Image size 1240x1240 · captured with the Phoenix ICON (100° field of view) · wide-field contact fundus photograph of an infant — 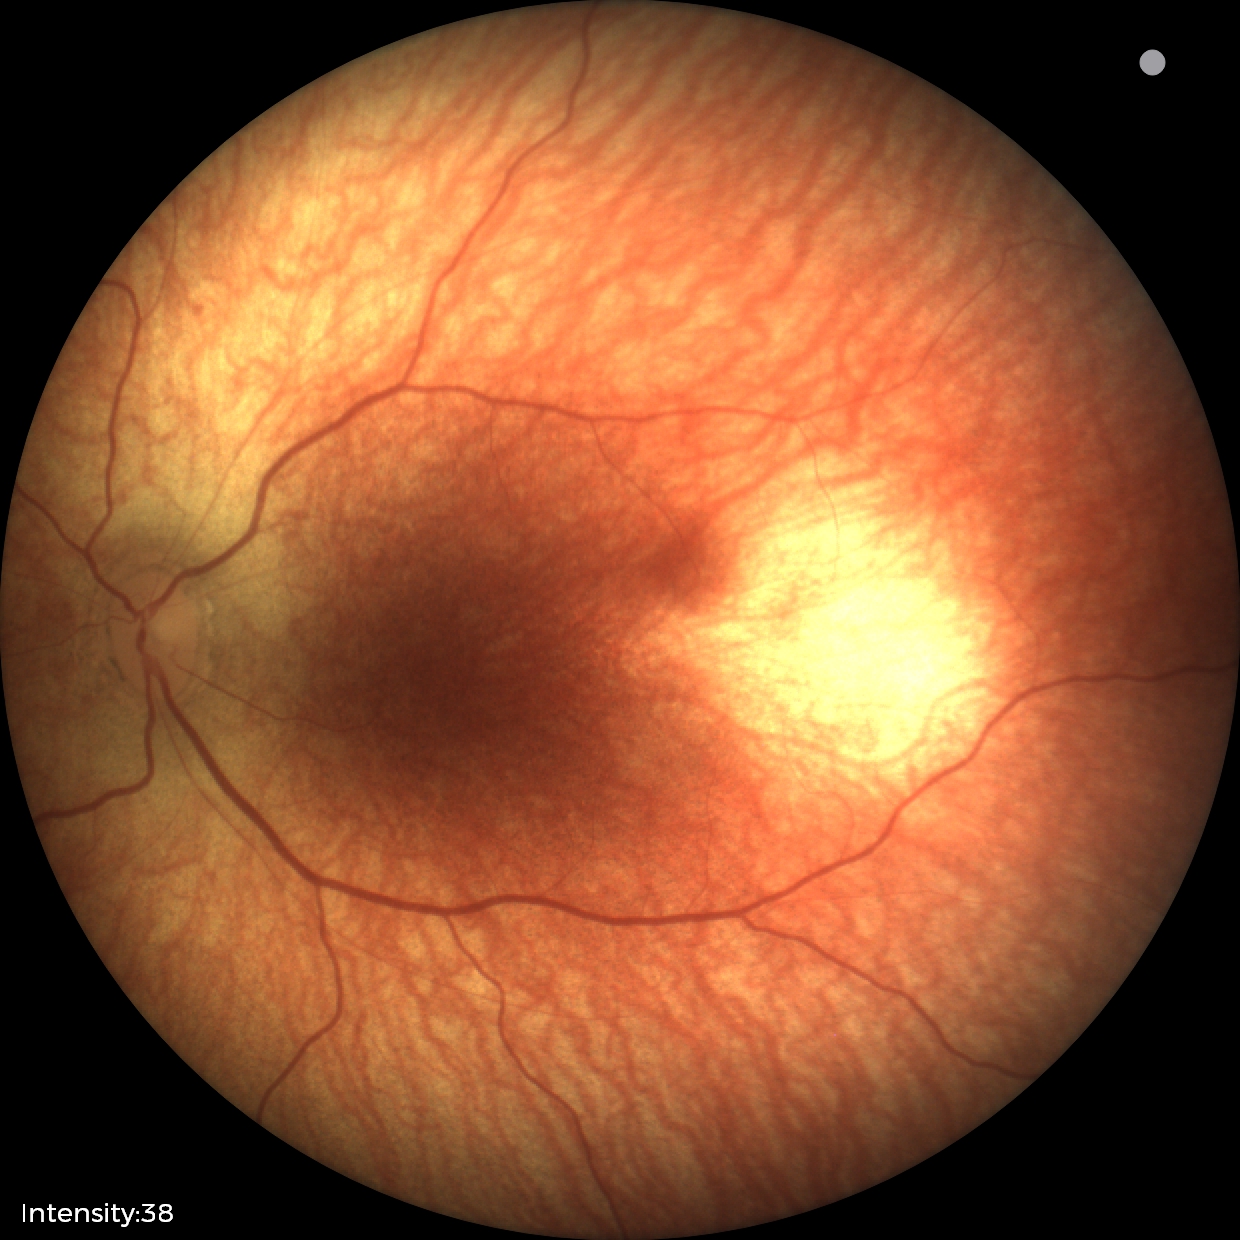
Diagnosis: normal retinal appearance